1240 x 1240 pixels. Infant wide-field fundus photograph. Phoenix ICON, 100° FOV: 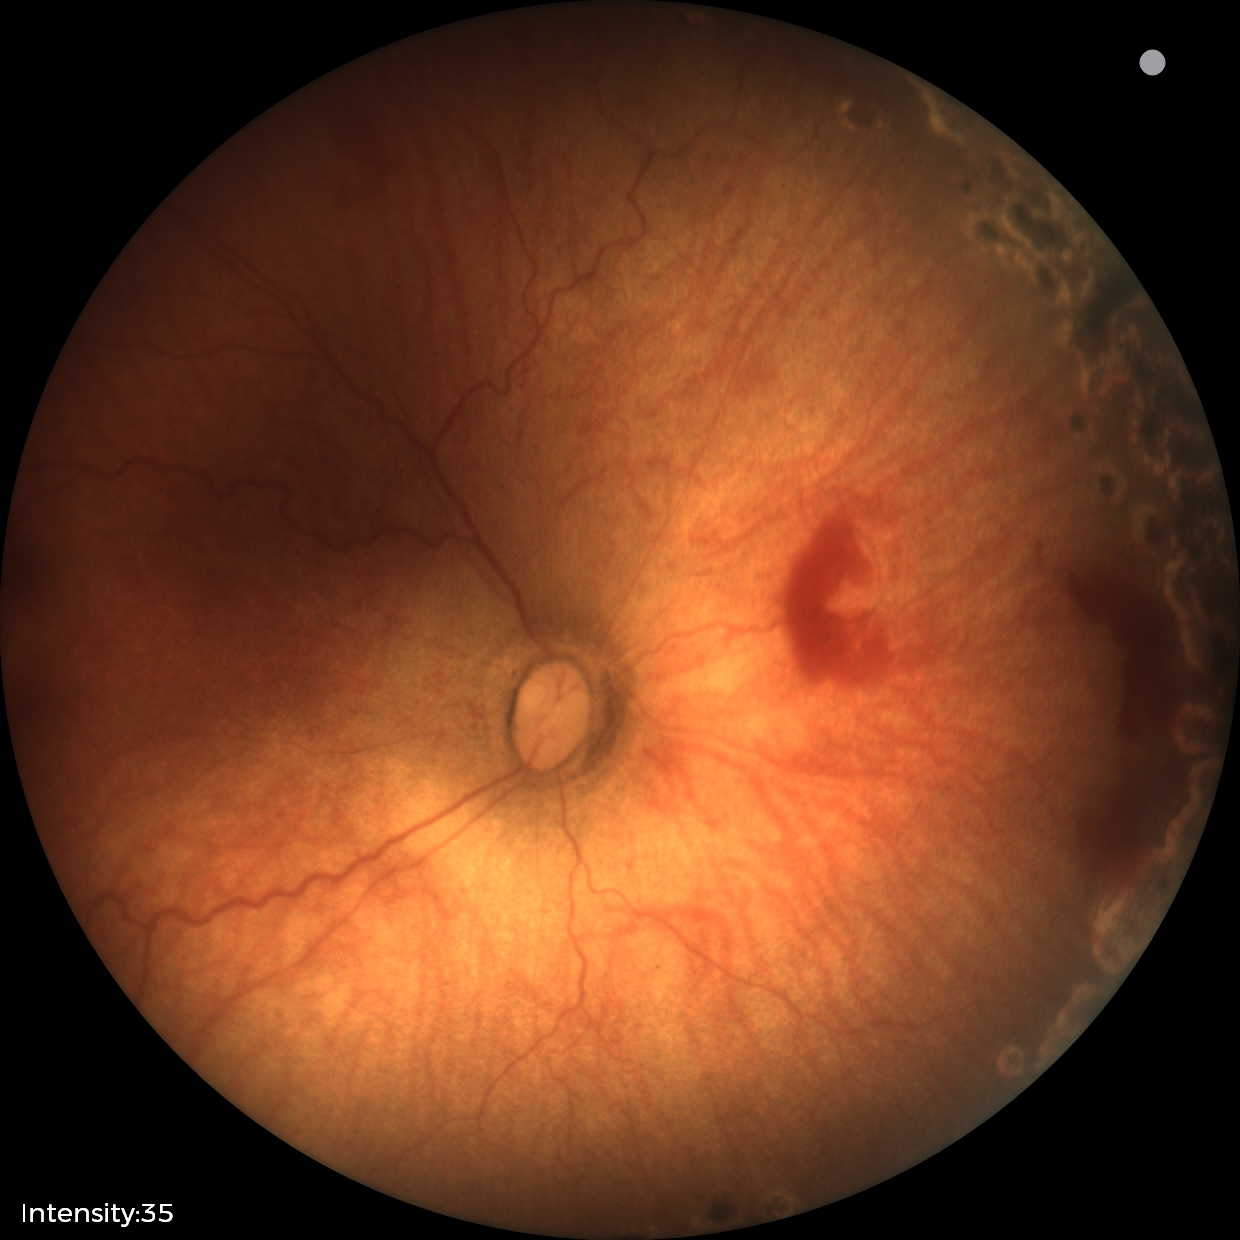

Series diagnosed as status post retinopathy of prematurity.
No plus disease.